Pediatric wide-field fundus photograph: 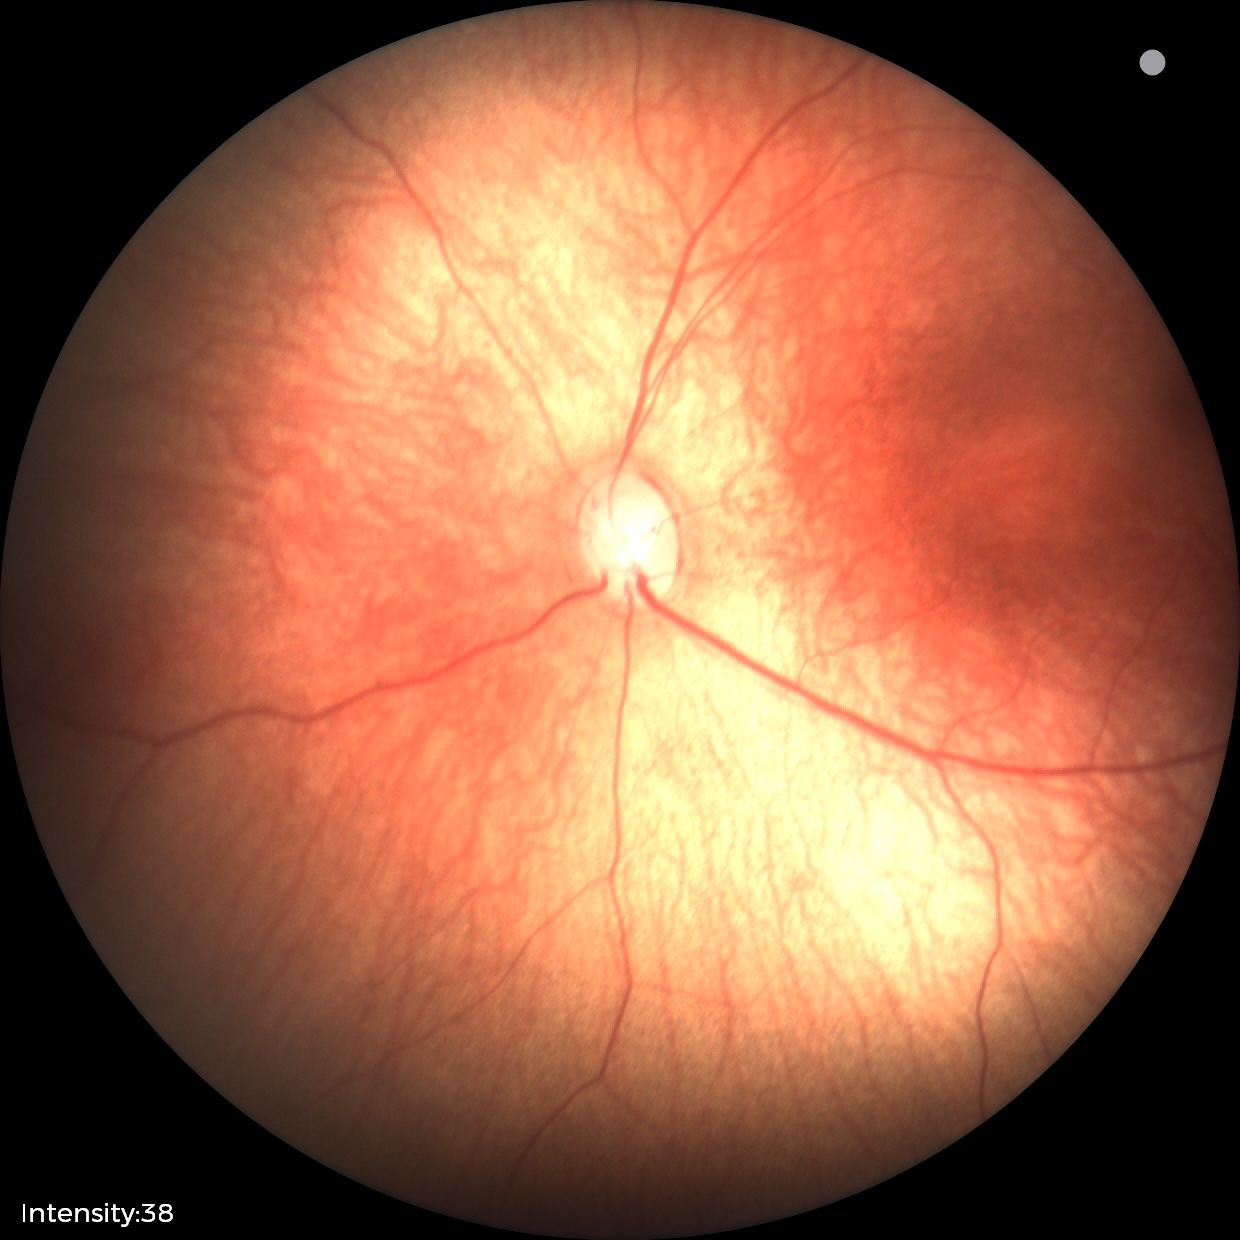

Diagnosis = normal retinal appearance.